Wide-field fundus photograph from neonatal ROP screening — 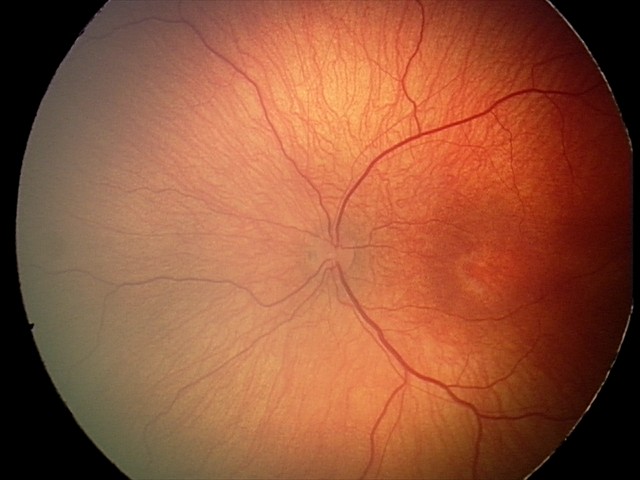 Screening examination consistent with retinopathy of prematurity (ROP) stage 2.